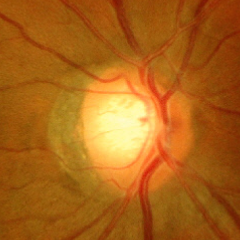
Q: What is the glaucoma diagnosis?
A: Yes — advanced glaucomatous optic neuropathy.